Optic nerve head crop; color fundus image.
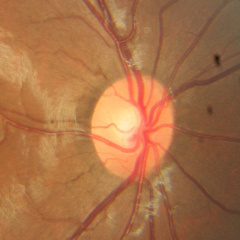 Glaucoma stage: no glaucomatous changes.